Acquired on the Phoenix ICON. Phoenix ICON wide-field infant fundus image:
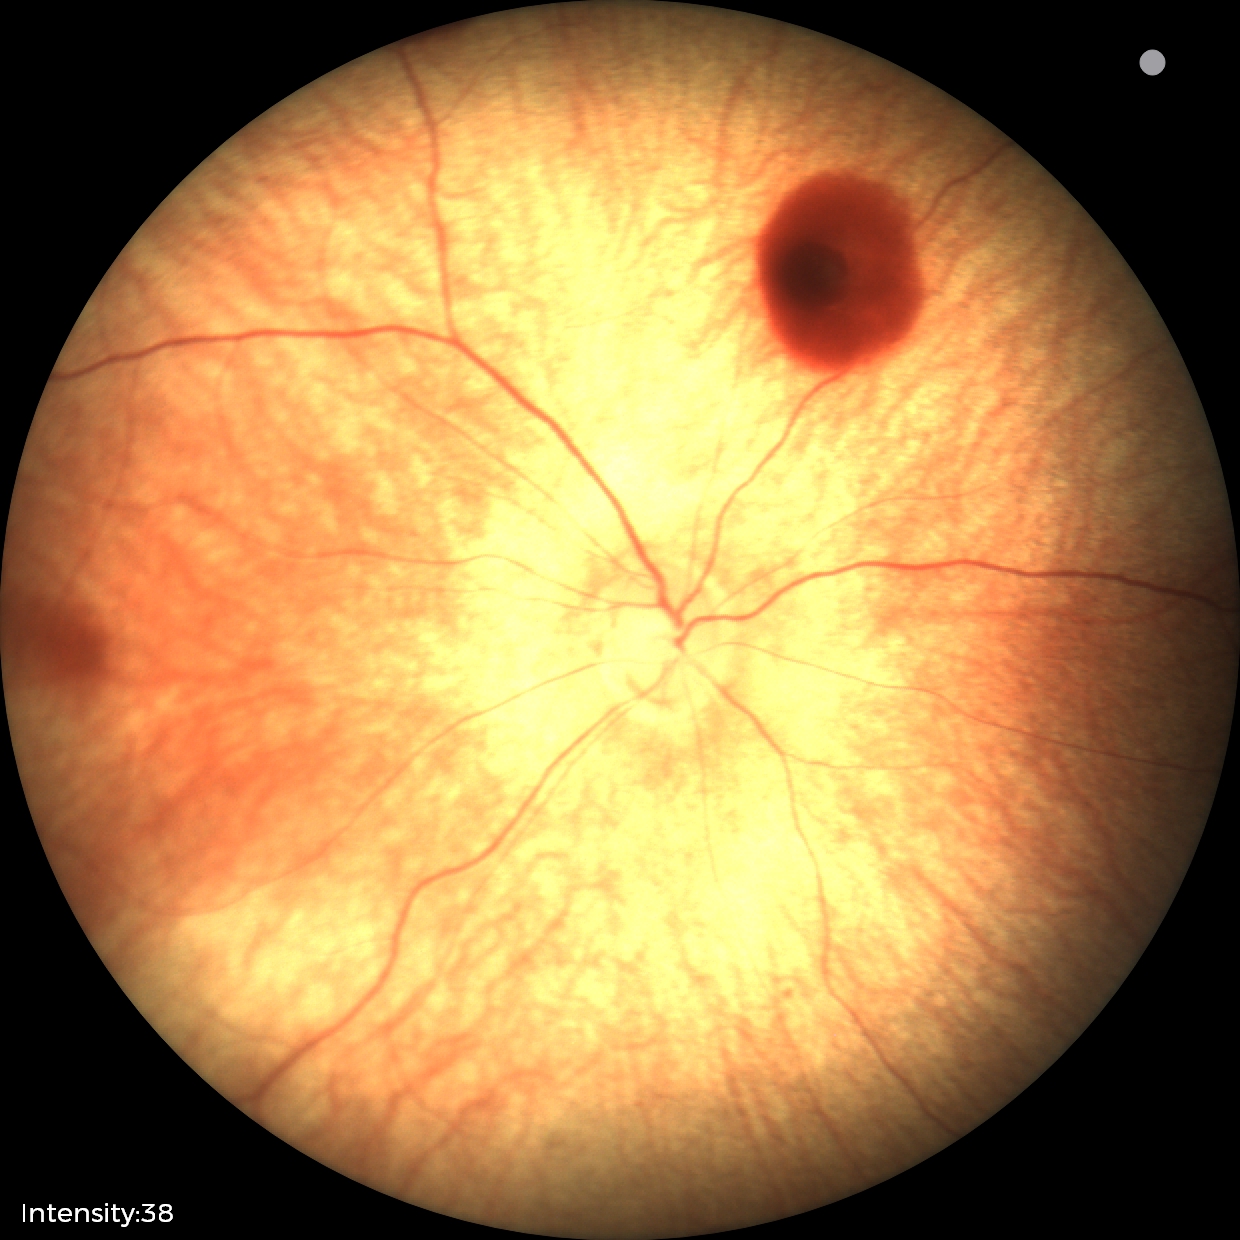

Diagnosis from this screening exam: retinal hemorrhages.